Modified Davis classification, color fundus photograph, NIDEK AFC-230.
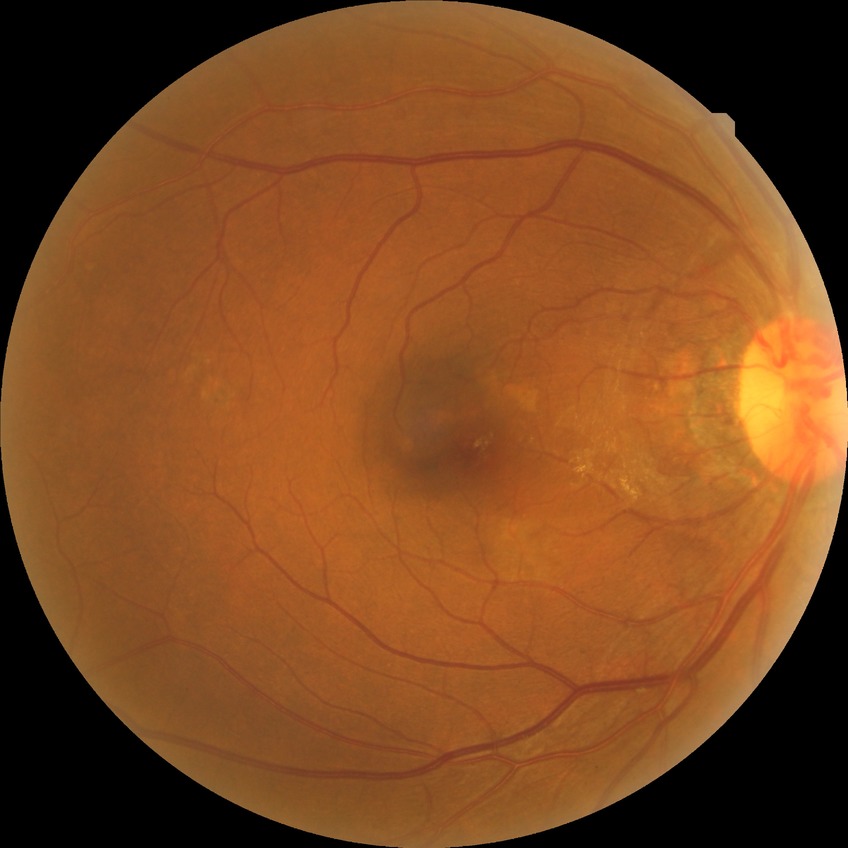
Modified Davis classification is no diabetic retinopathy.